Acquired on the Clarity RetCam 3 · 640x480px · pediatric wide-field fundus photograph — 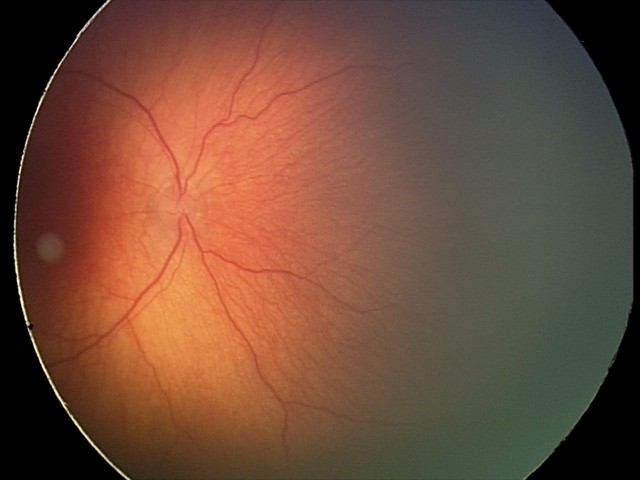
Screening diagnosis: status post ROP — retinal appearance after treated retinopathy of prematurity | no plus disease.